FOV: 45 degrees, 2048 by 1536 pixels: 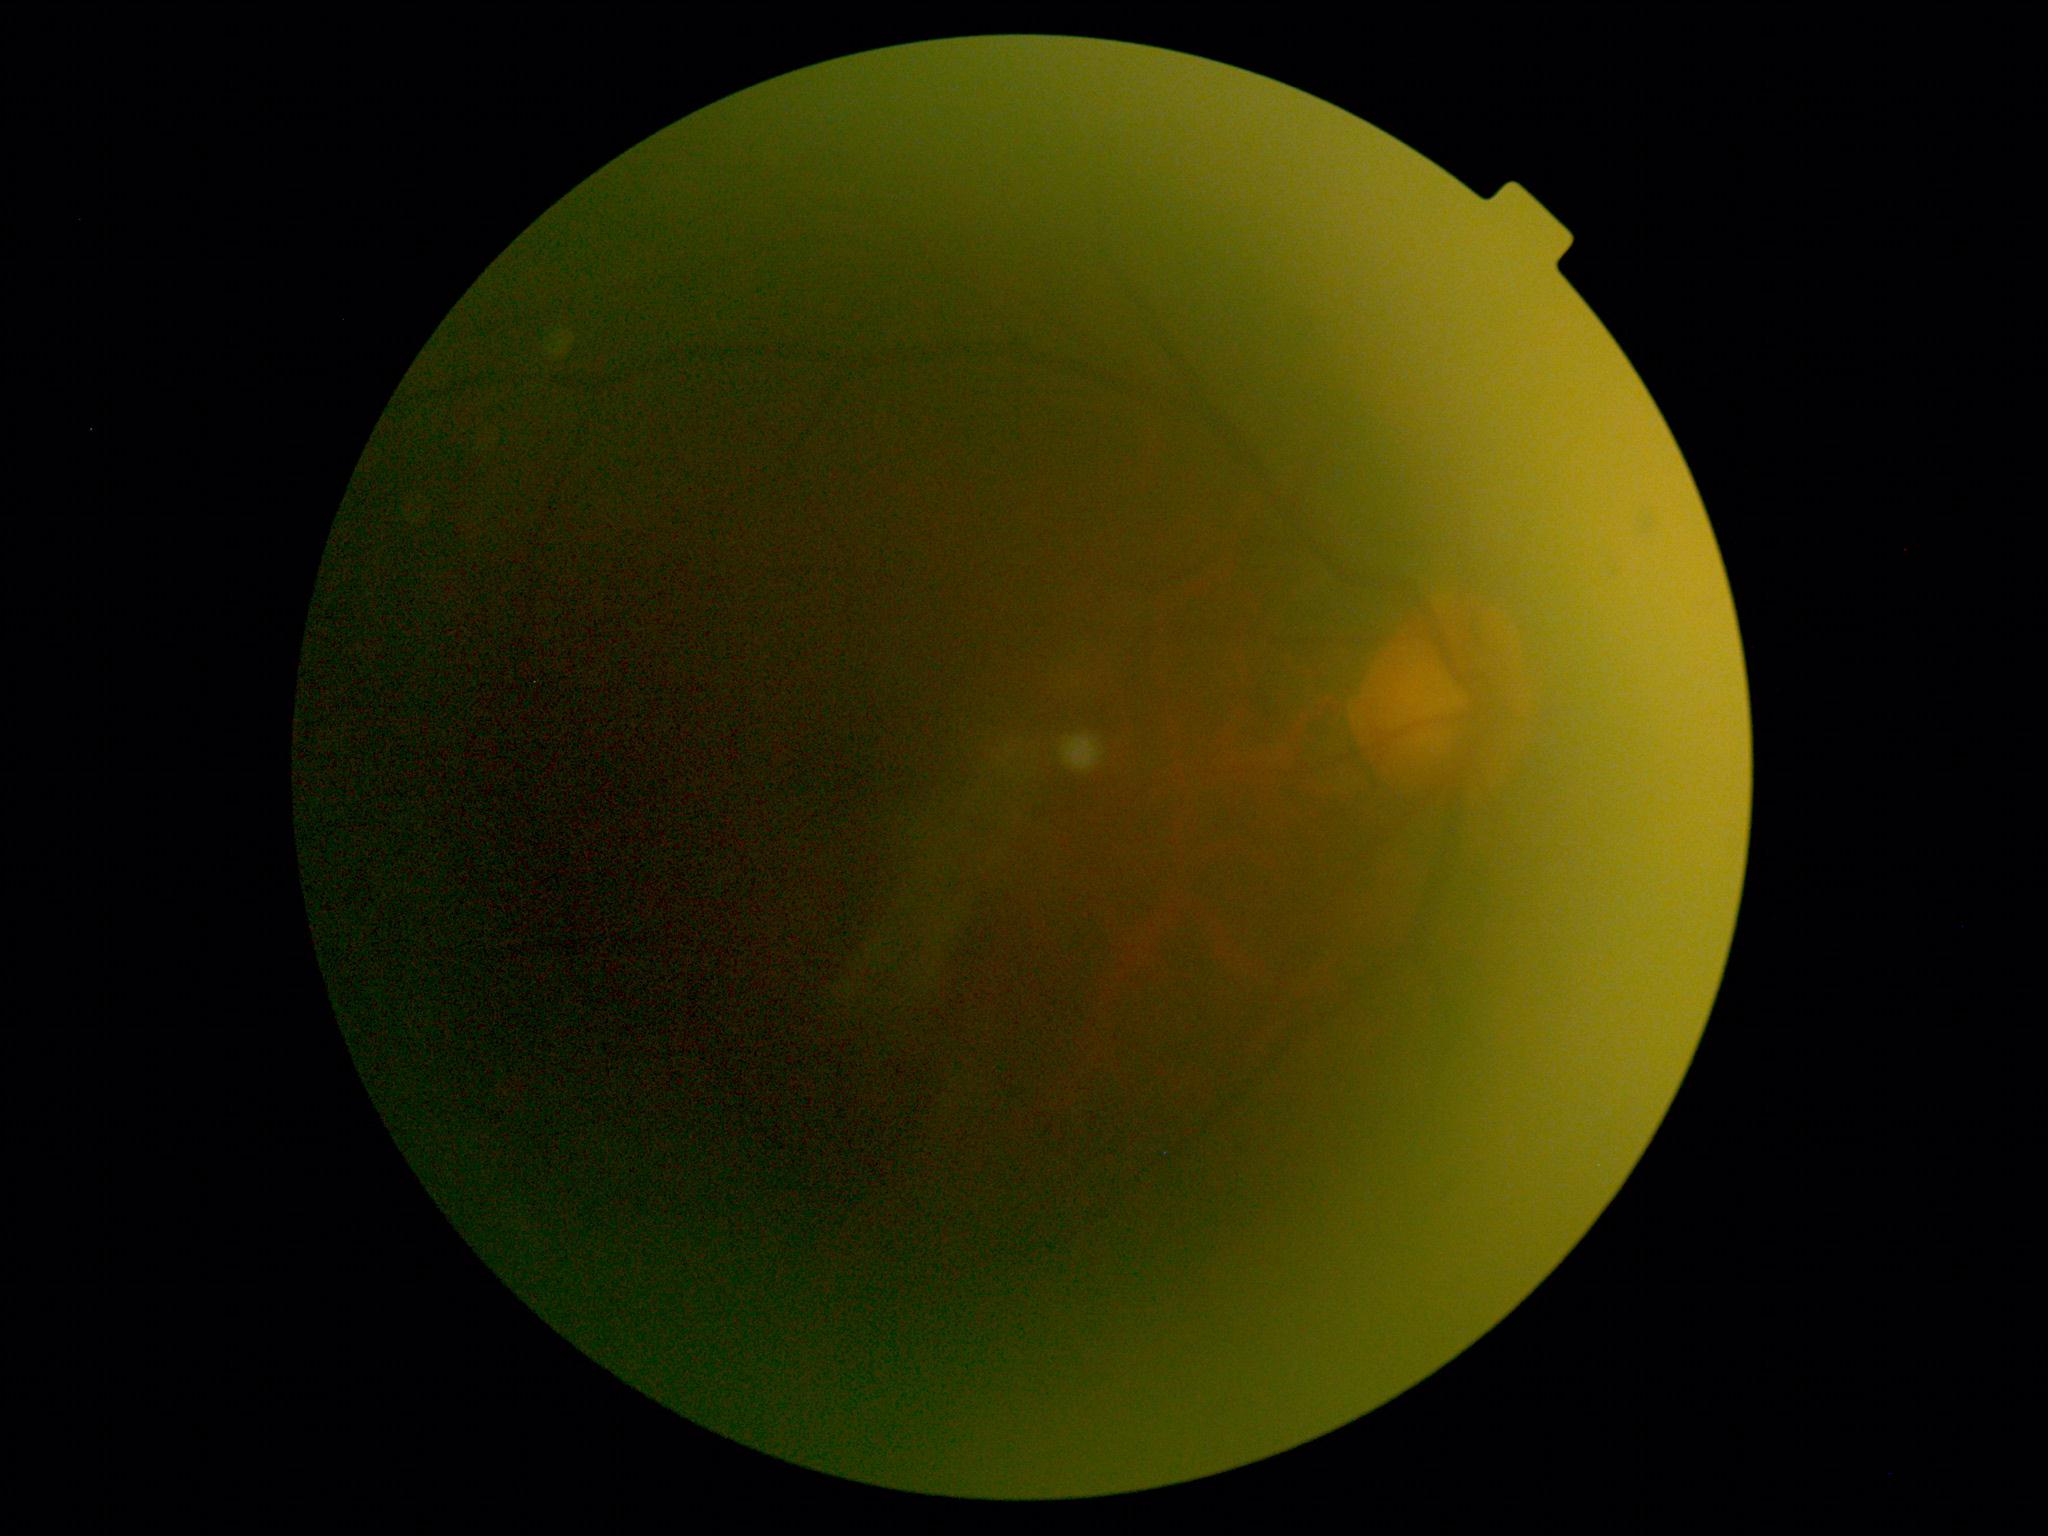

The image cannot be graded for diabetic retinopathy.
DR: ungradable due to poor image quality.